Fundus photo, nonmydriatic
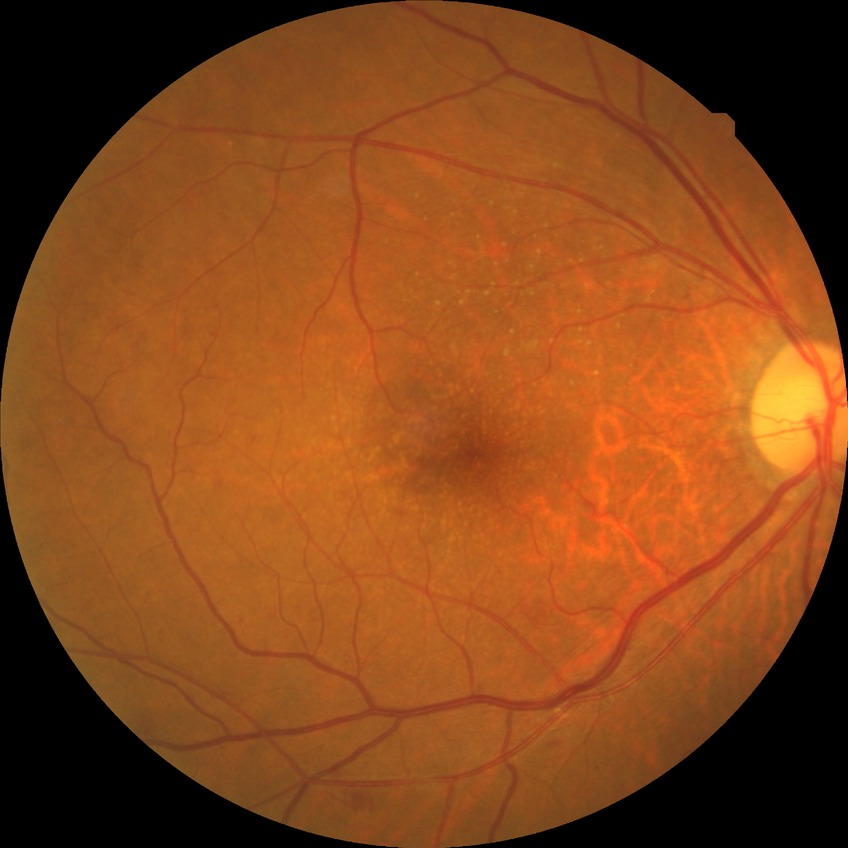

{
  "davis_grade": "no diabetic retinopathy"
}